2048x1536: 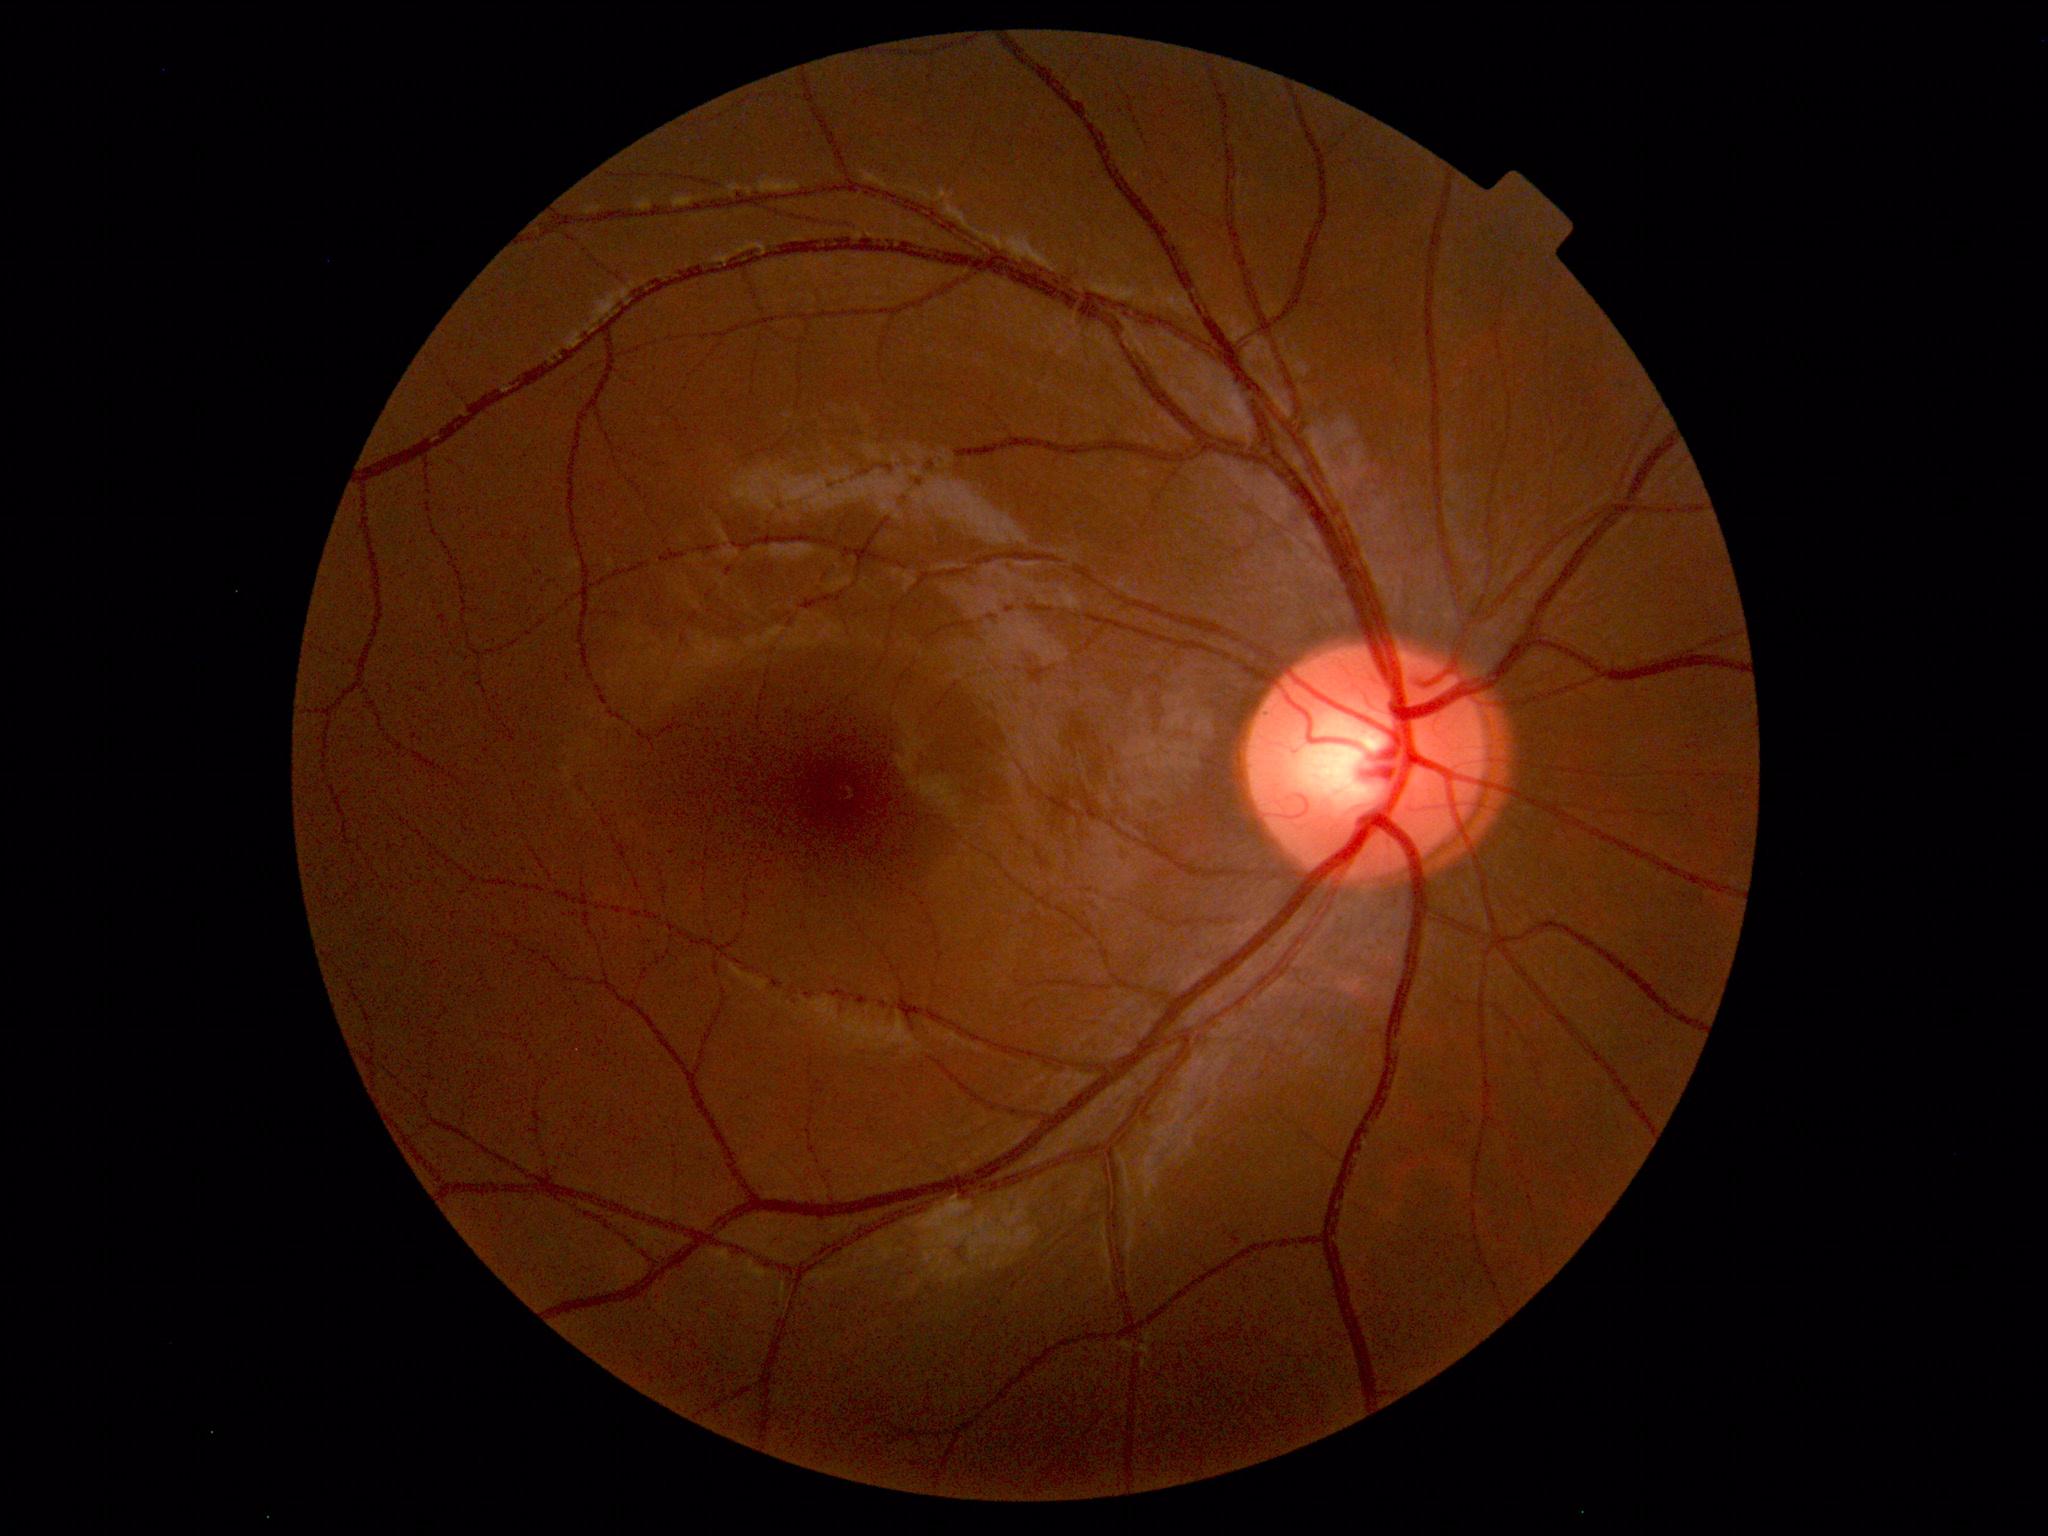
Unremarkable color fundus photograph.